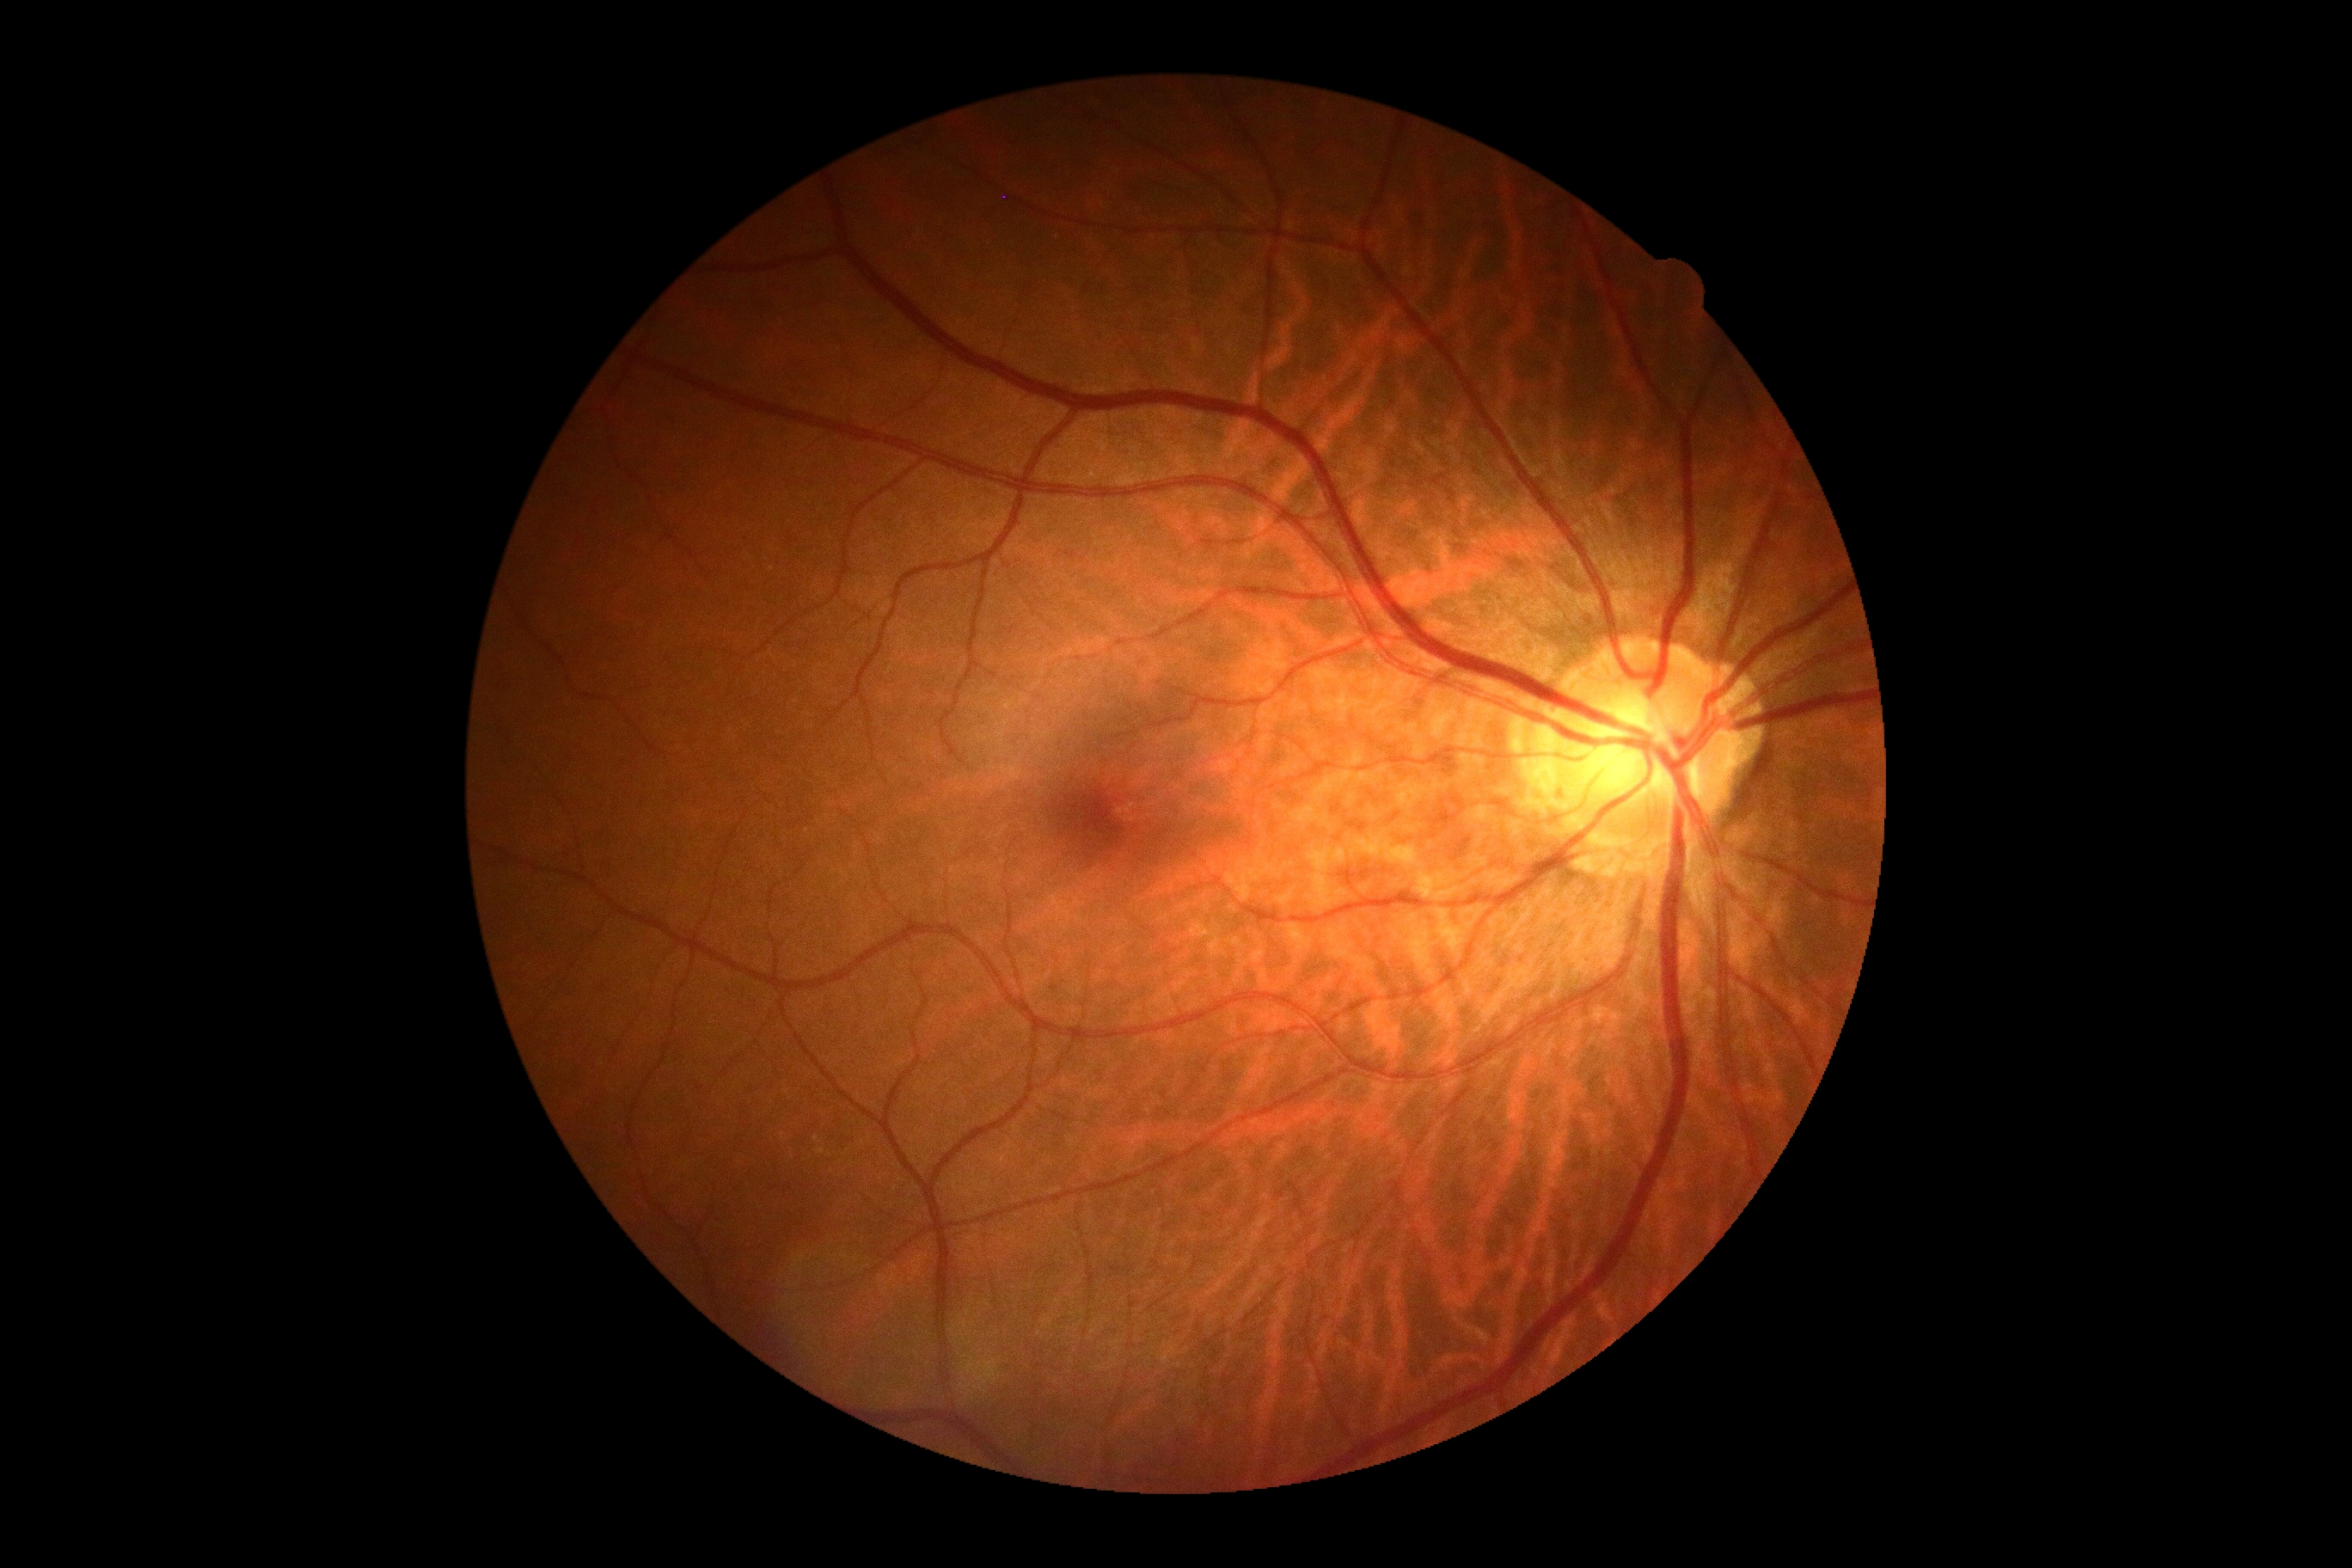
Diabetic retinopathy grade is no apparent diabetic retinopathy (0).